848 by 848 pixels:
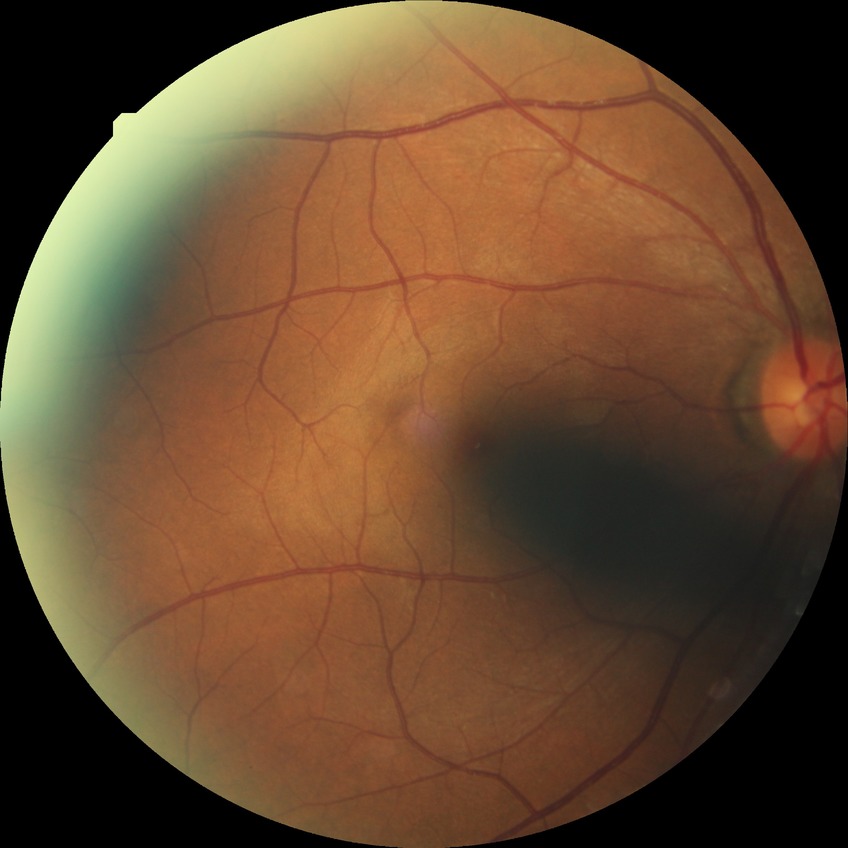
Diabetic retinopathy (DR): SDR (simple diabetic retinopathy).
Disease class: non-proliferative diabetic retinopathy.